45-degree field of view
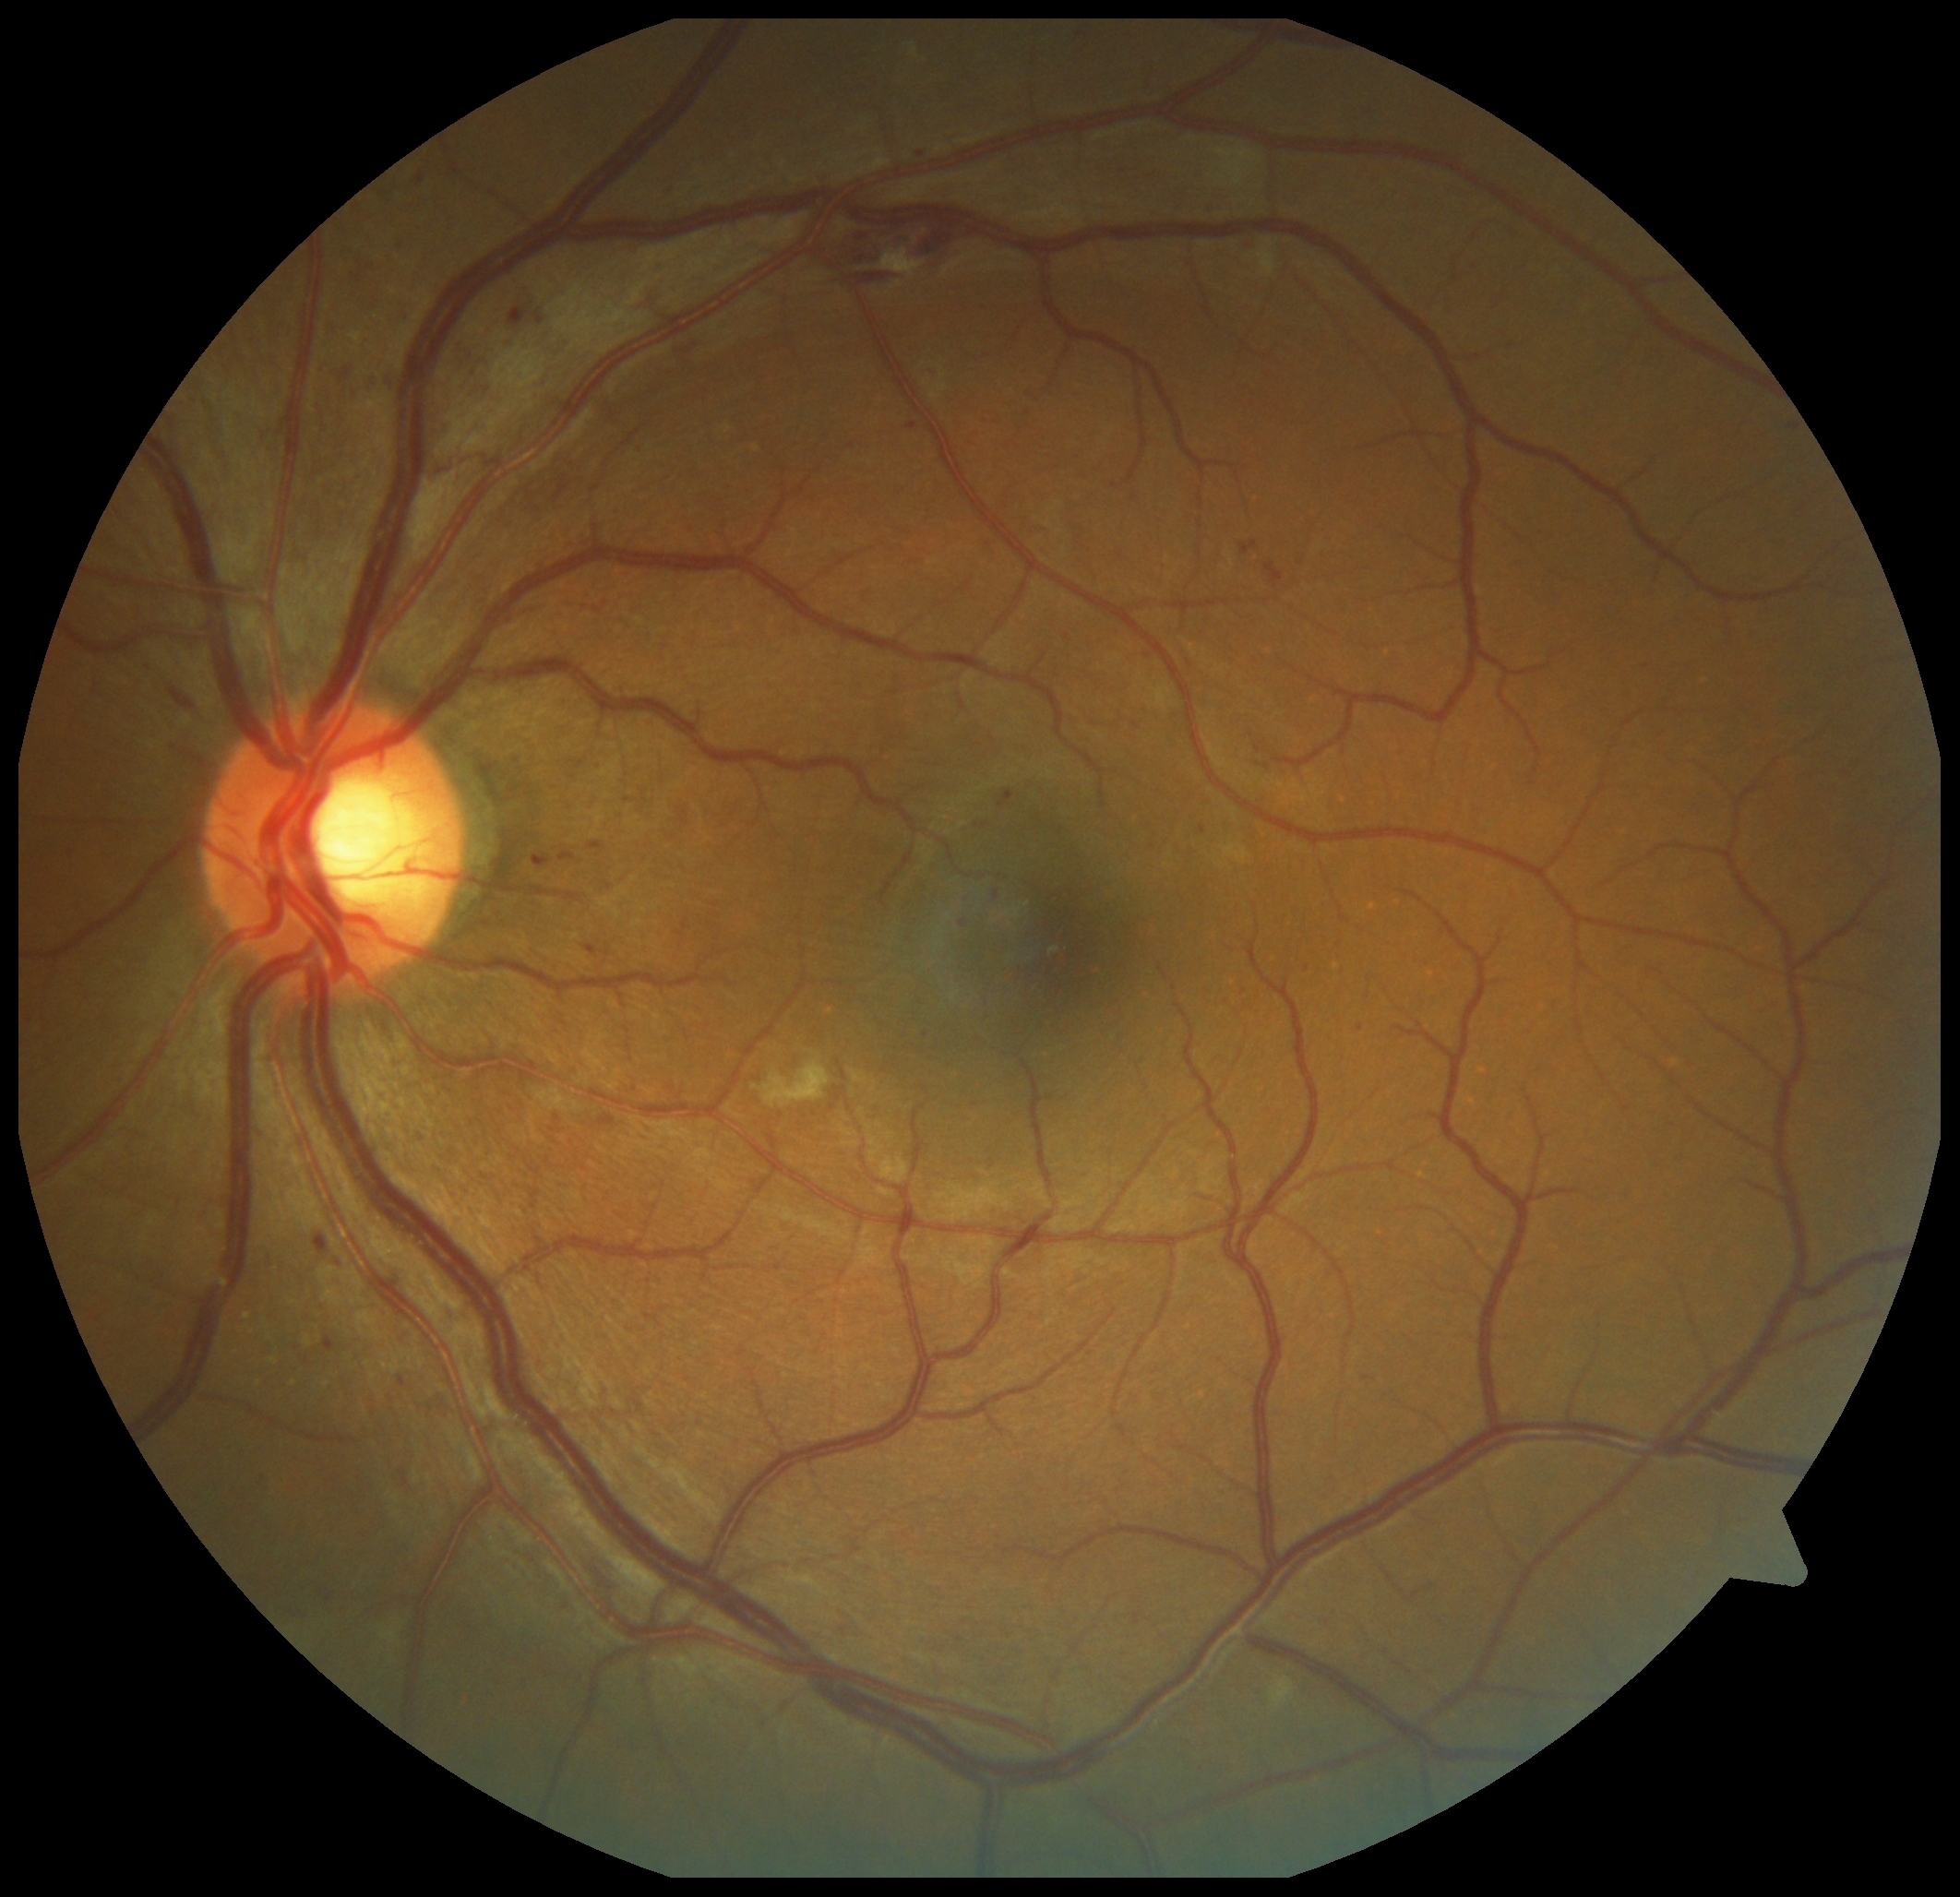

partial: true
dr_grade: 2
dr_grade_name: moderate NPDR
lesions:
  ma:
    - bbox(908, 424, 917, 431)
    - bbox(560, 853, 576, 863)
    - bbox(995, 892, 1000, 901)
    - bbox(315, 1236, 329, 1253)
    - bbox(587, 945, 598, 955)
    - bbox(591, 841, 602, 850)
    - bbox(998, 791, 1015, 808)
    - bbox(558, 1603, 572, 1612)
    - bbox(326, 1593, 333, 1603)
    - bbox(329, 364, 344, 378)
    - bbox(324, 1336, 335, 1353)
  ma_small_centers:
    - pt(541, 321)
    - pt(925, 1034)
    - pt(1149, 656)
    - pt(1268, 767)
    - pt(1204, 830)